Infant wide-field retinal image:
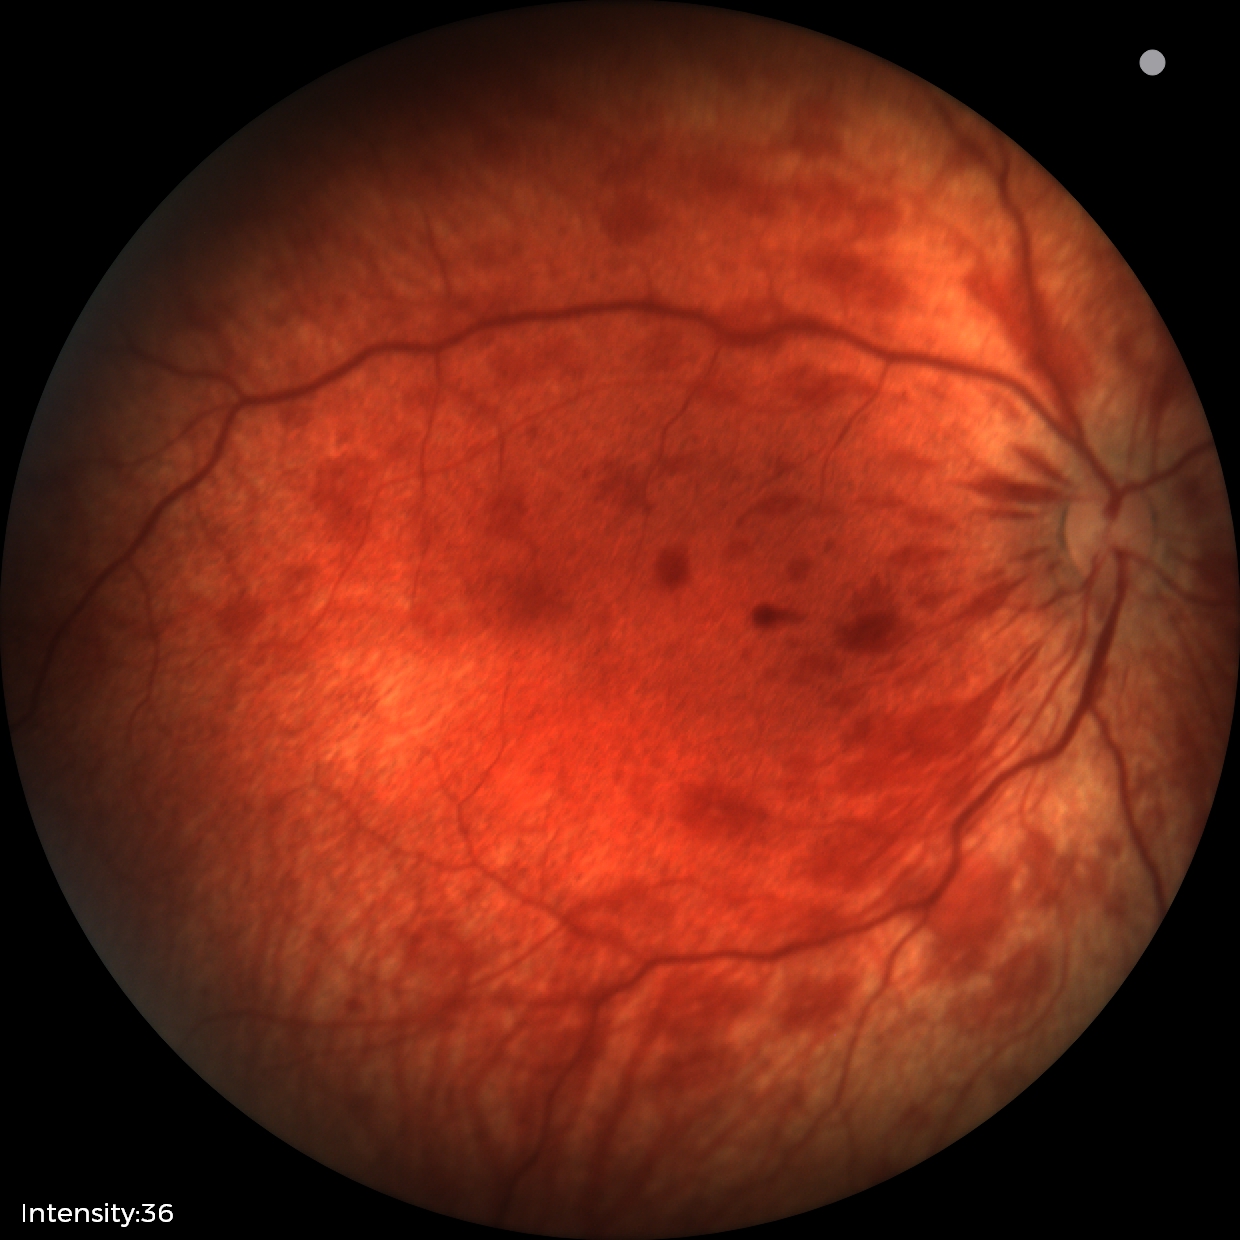 Examination diagnosed as retinal hemorrhages.